Without pupil dilation. Modified Davis classification. 848x848:
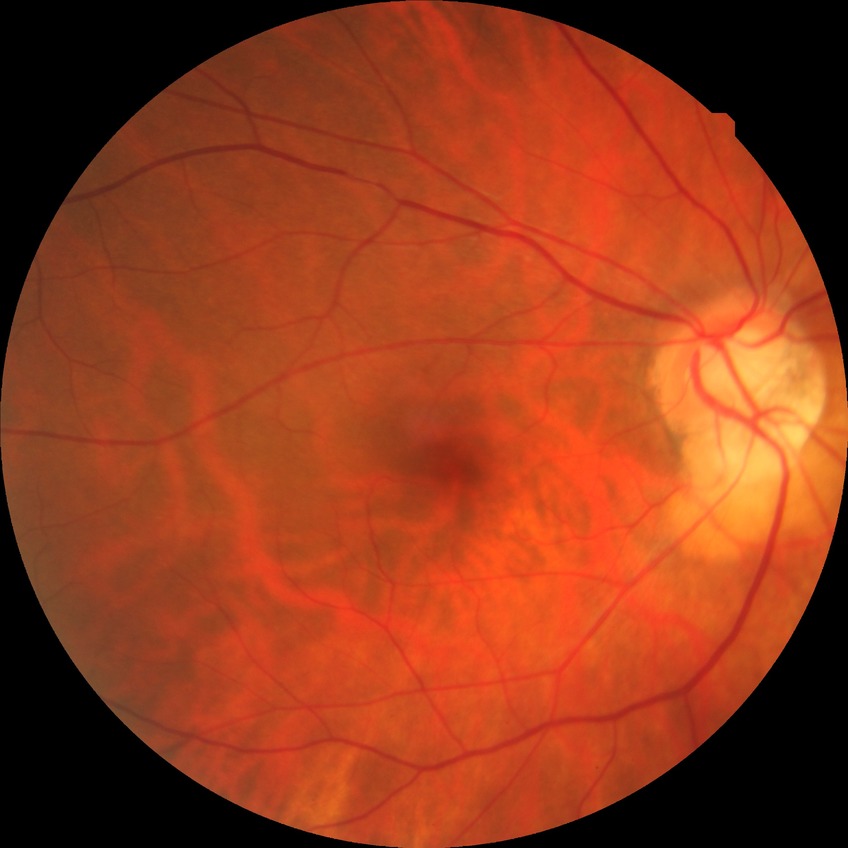

{
  "davis_grade": "no diabetic retinopathy"
}